Graded on the modified Davis scale:
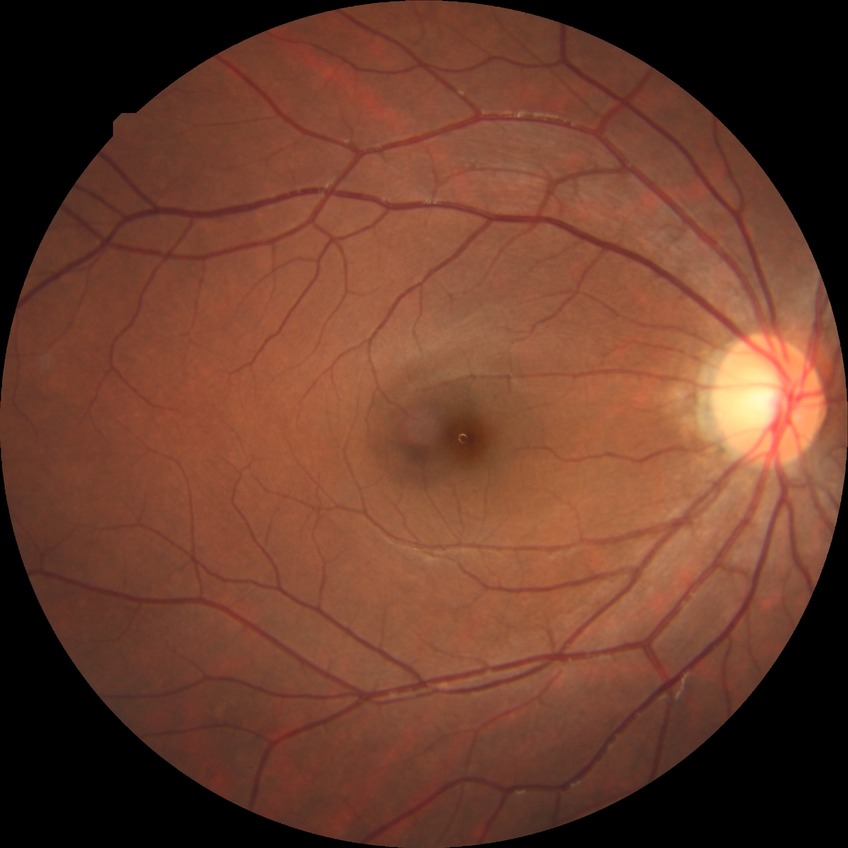

{
  "davis_grade": "NDR"
}